Retinal fundus photograph. 848x848px:
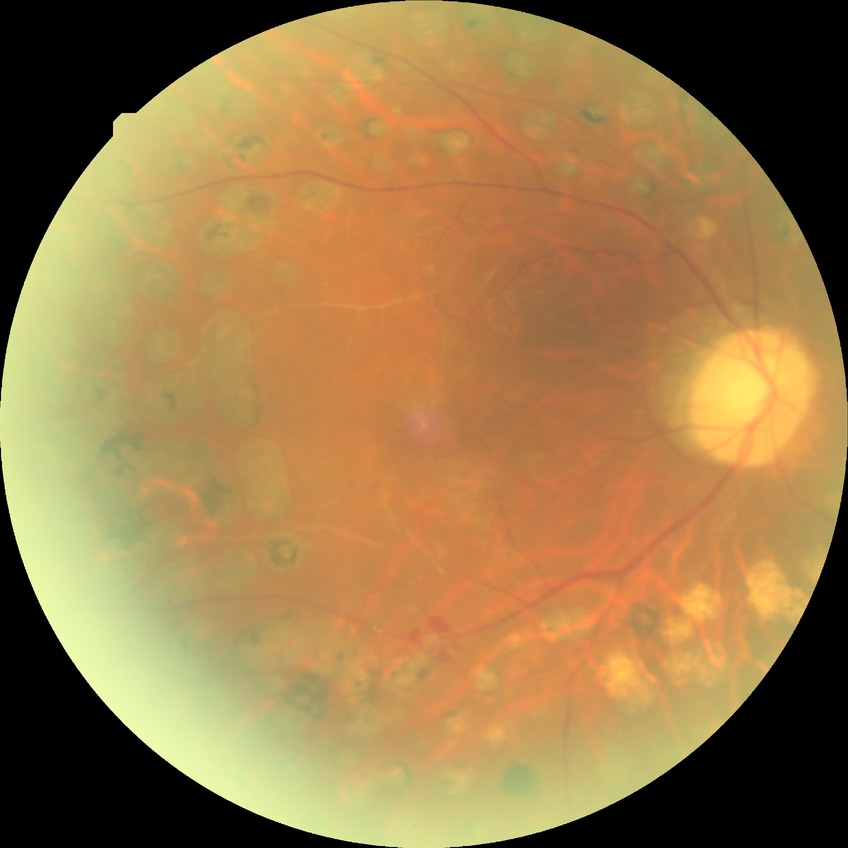
Davis grading is proliferative diabetic retinopathy.